Image size 1240x1240. Camera: Phoenix ICON (100° FOV). Infant wide-field fundus photograph — 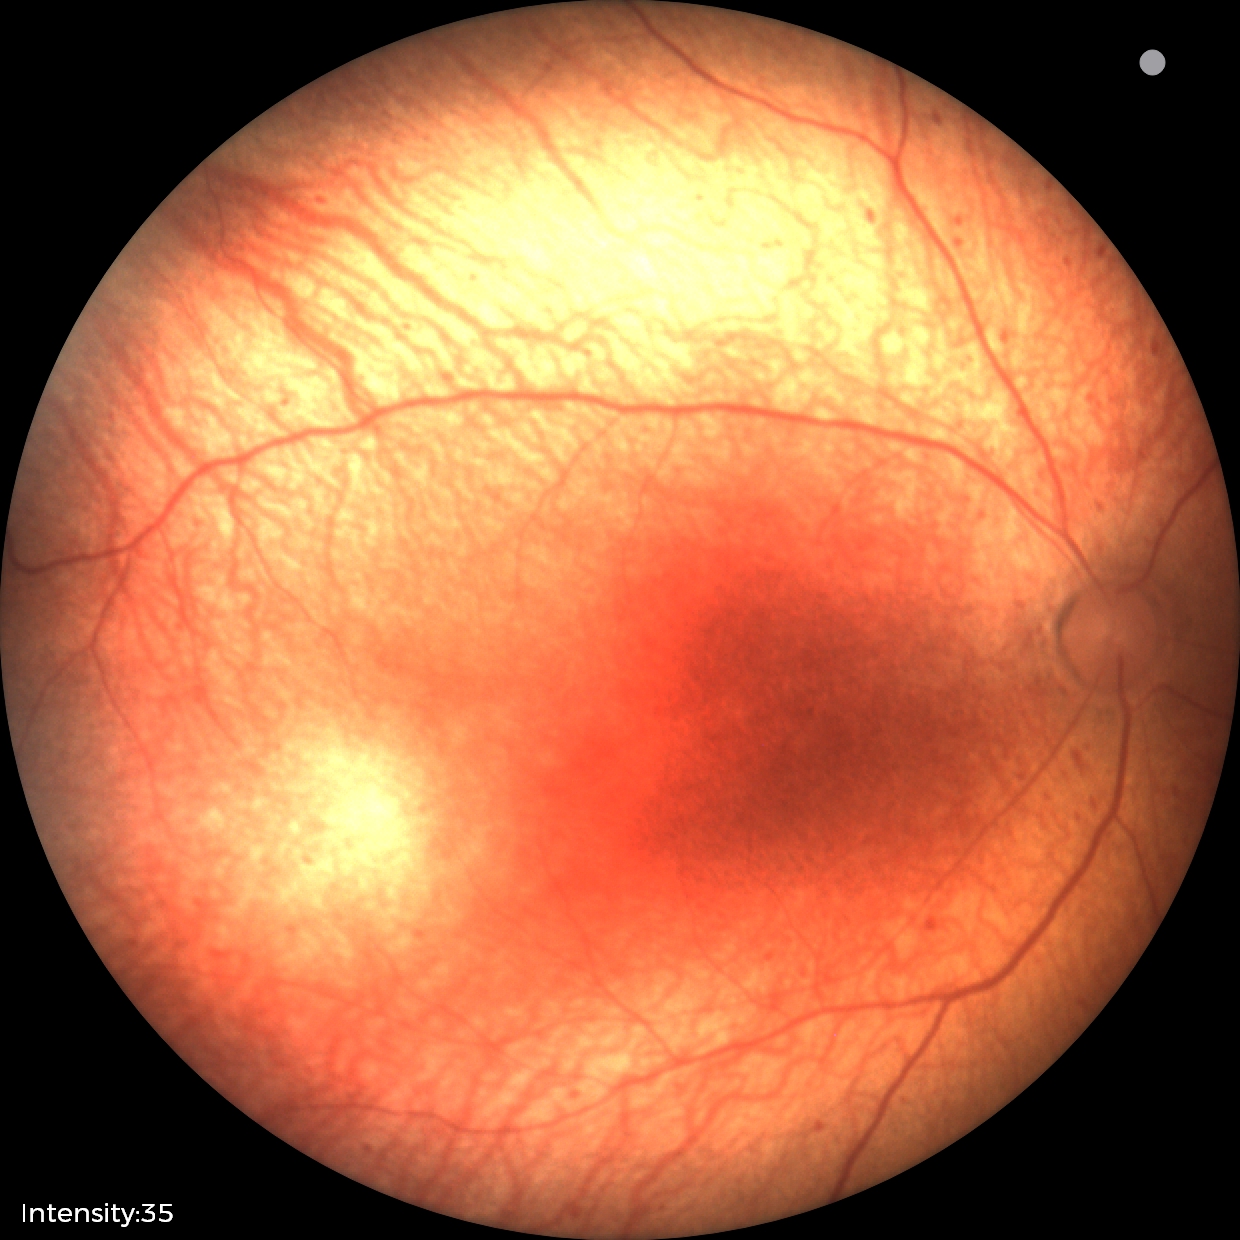

No plus disease. Screening examination consistent with status post retinopathy of prematurity (ROP).